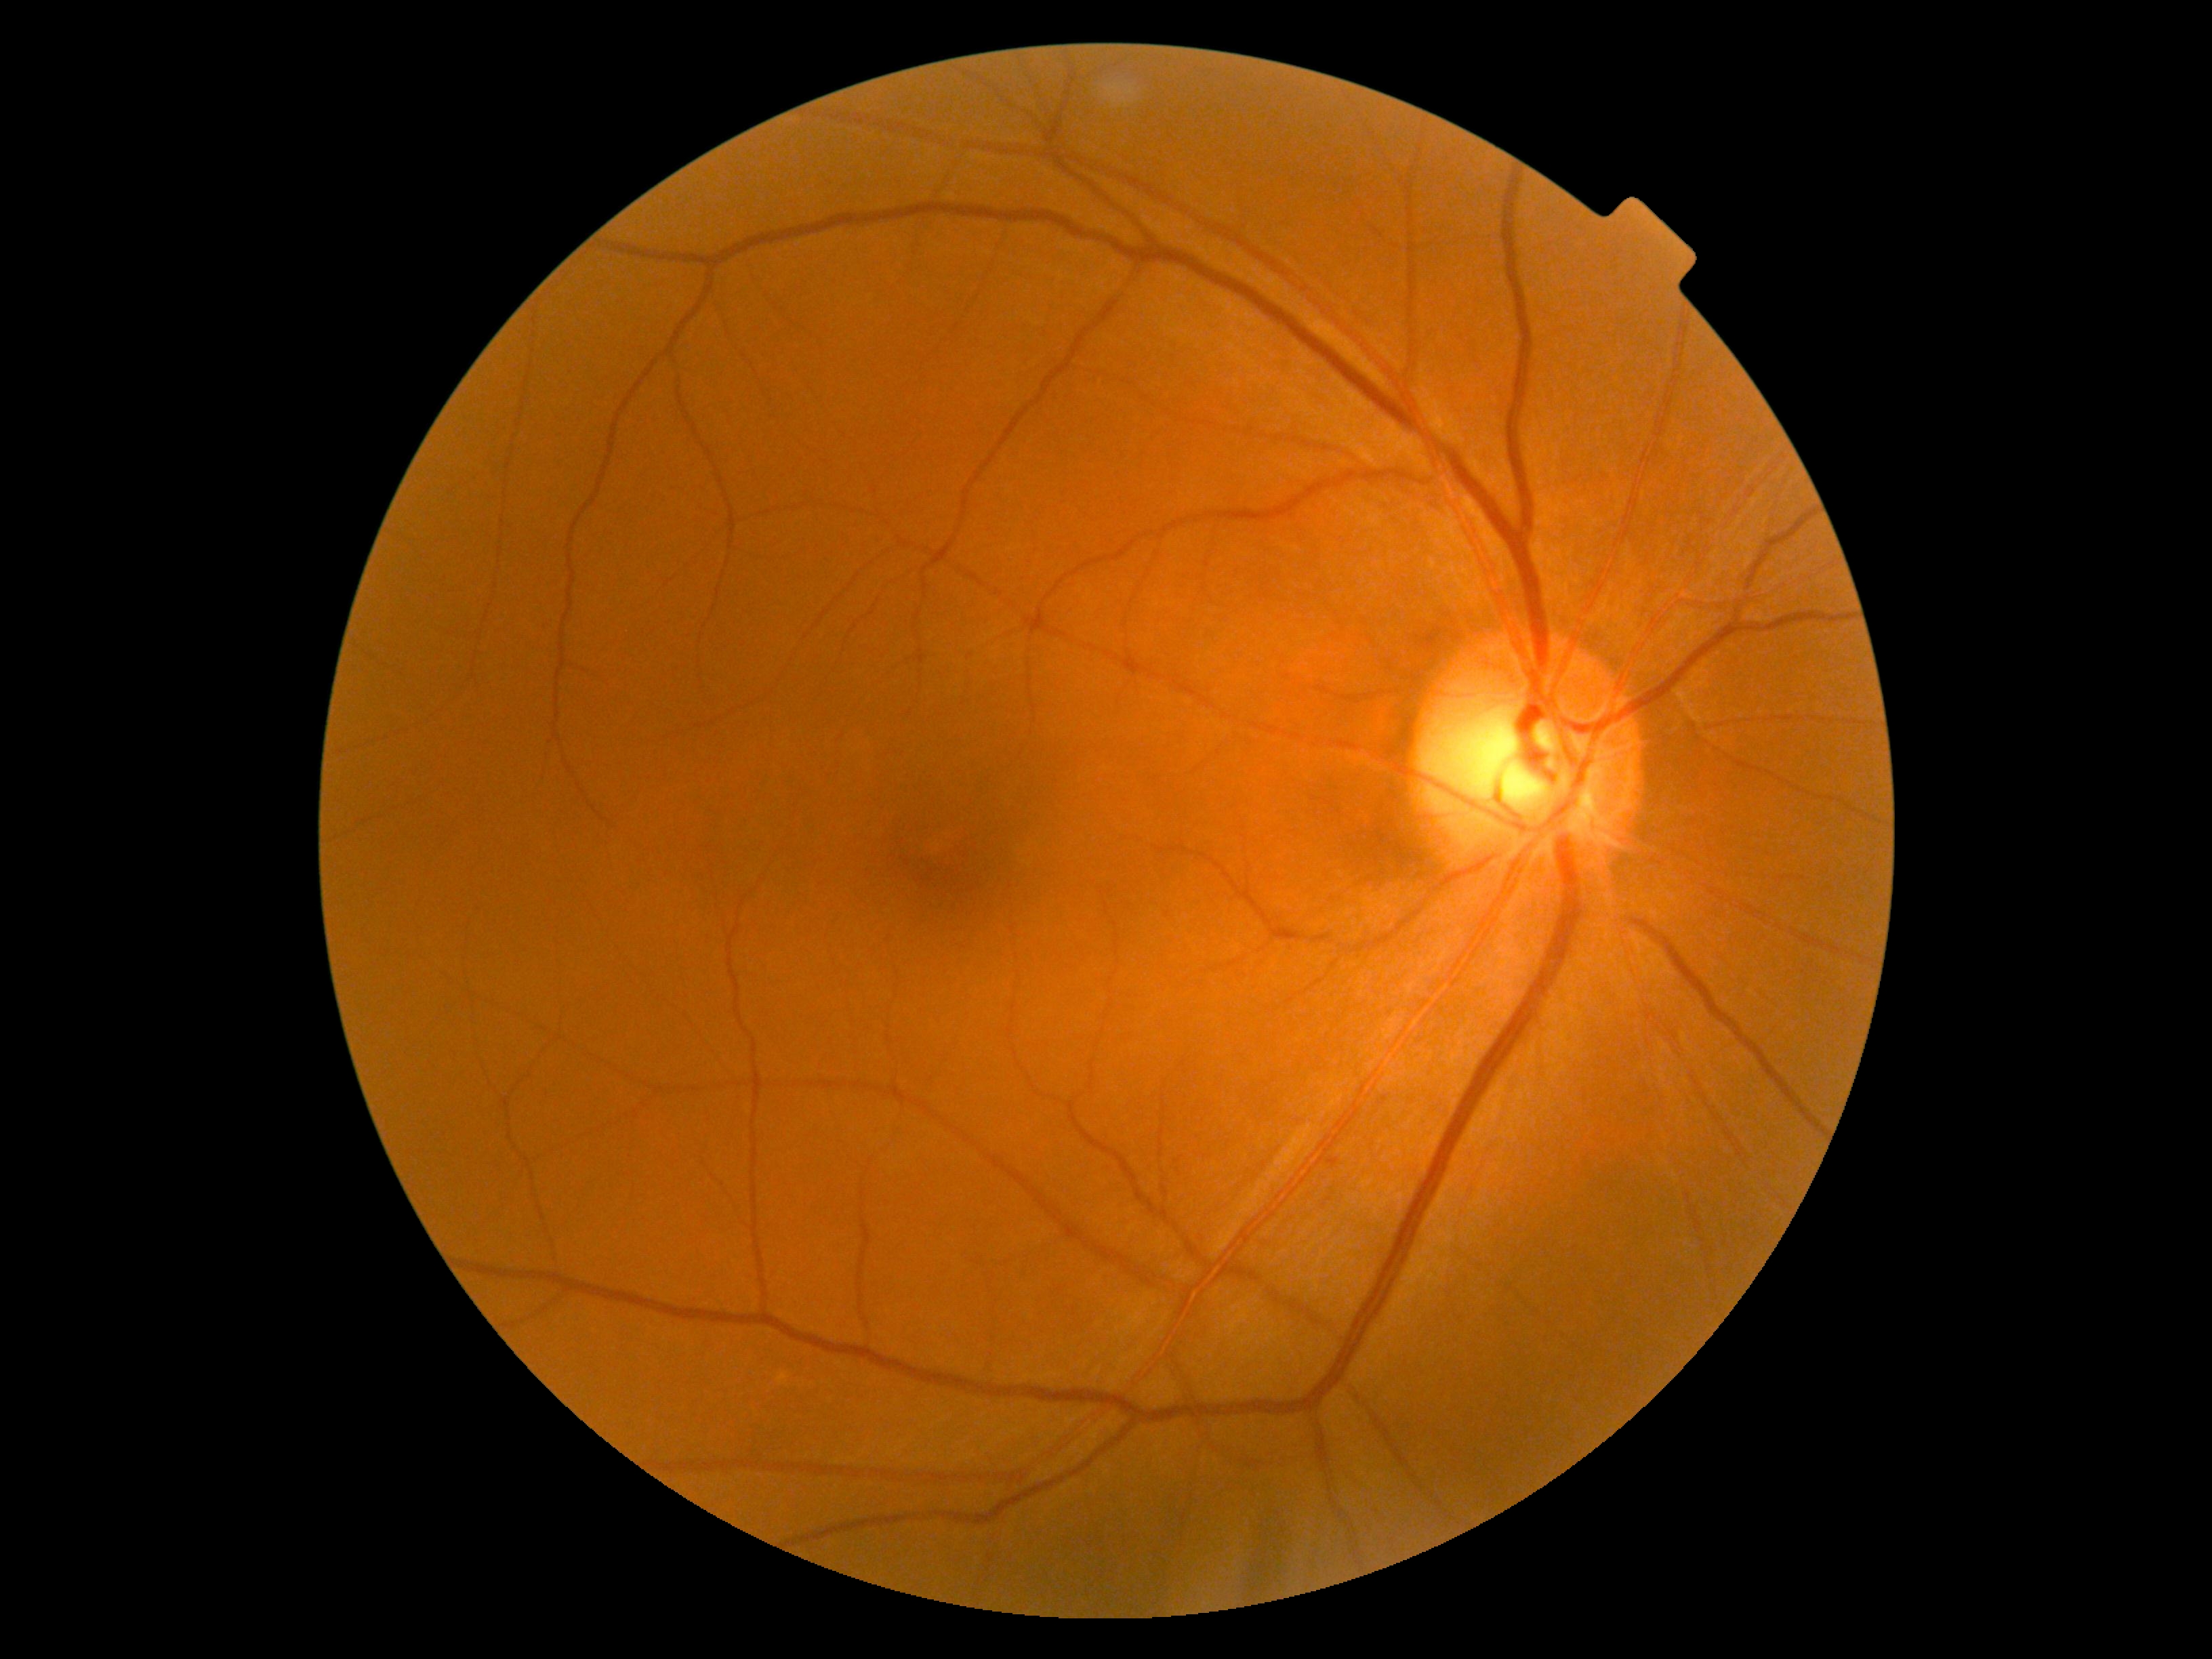 DR impression: no apparent DR; DR stage: grade 0 (no apparent retinopathy).